Wide-field fundus photograph from neonatal ROP screening.
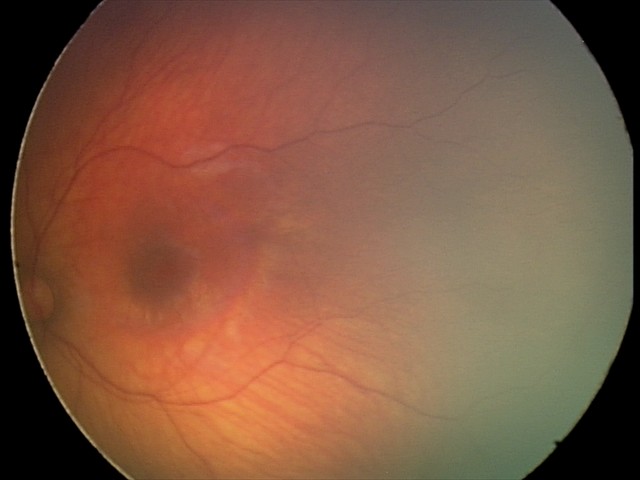

Diagnosis from this screening exam: retinal hemorrhages.